848x848px, diabetic retinopathy graded by the modified Davis classification, retinal fundus photograph: 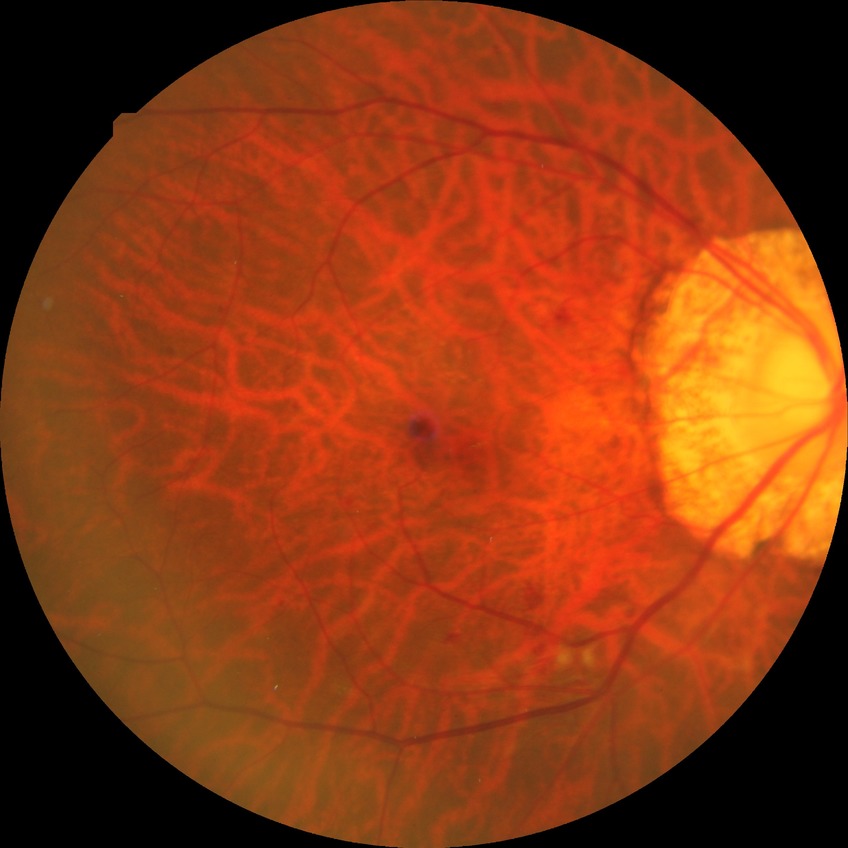 Davis grading: pre-proliferative diabetic retinopathy.